Pediatric wide-field fundus photograph. 1240 by 1240 pixels.
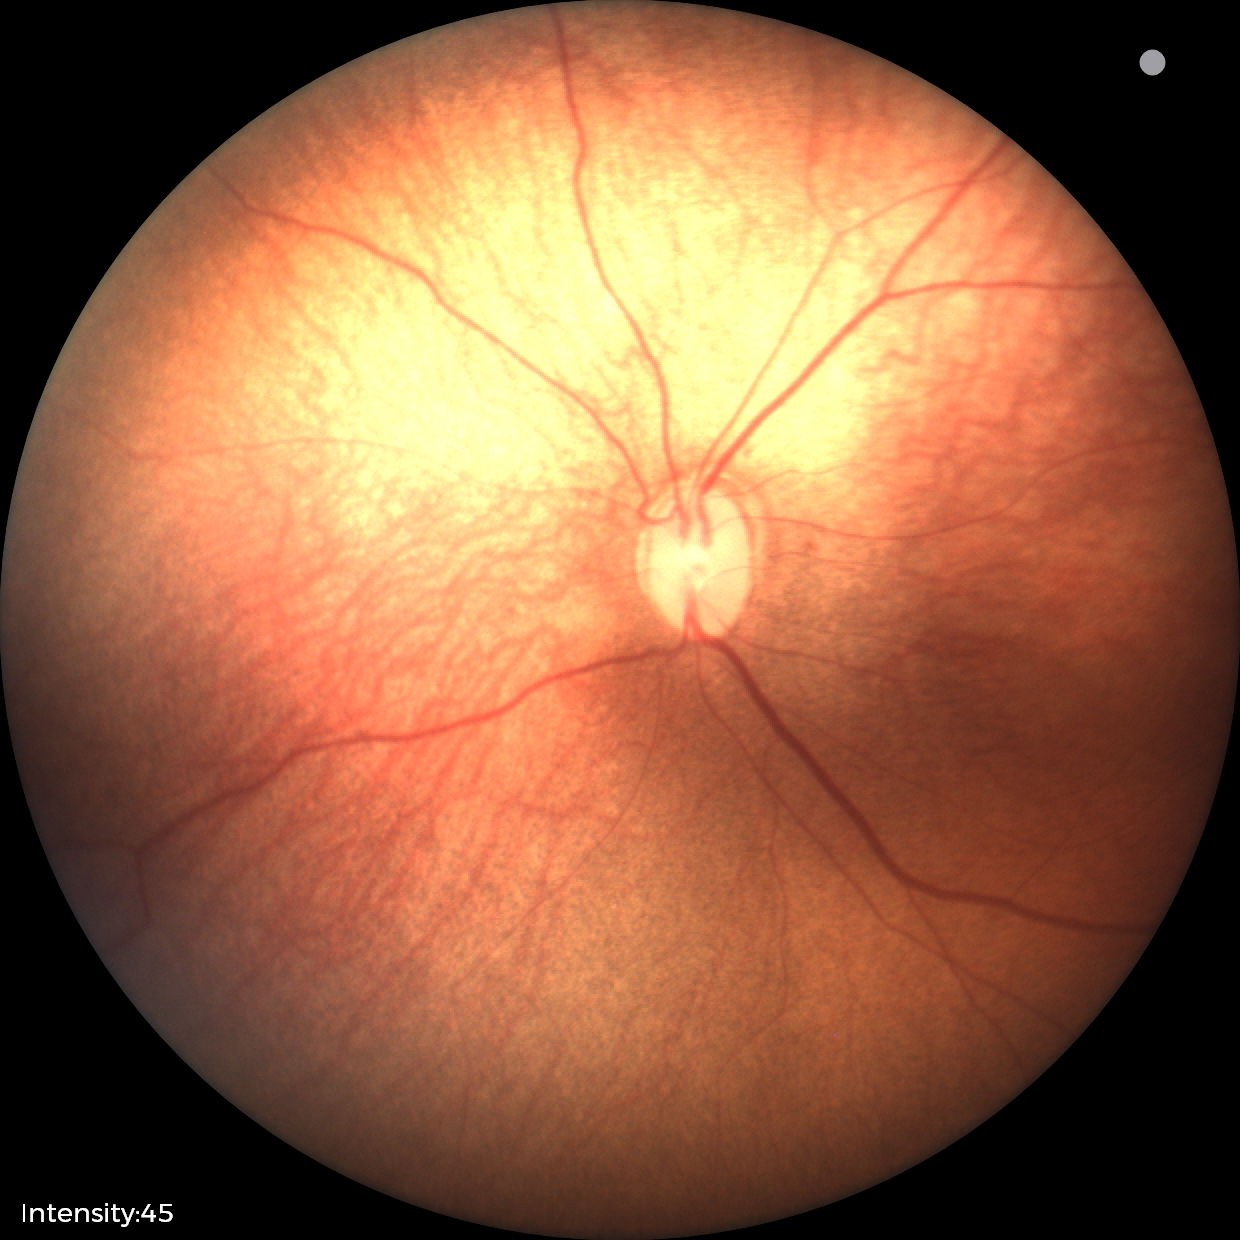

Screening diagnosis: retinopathy of prematurity stage 1.